Image size 2352x1568, retinal fundus photograph:
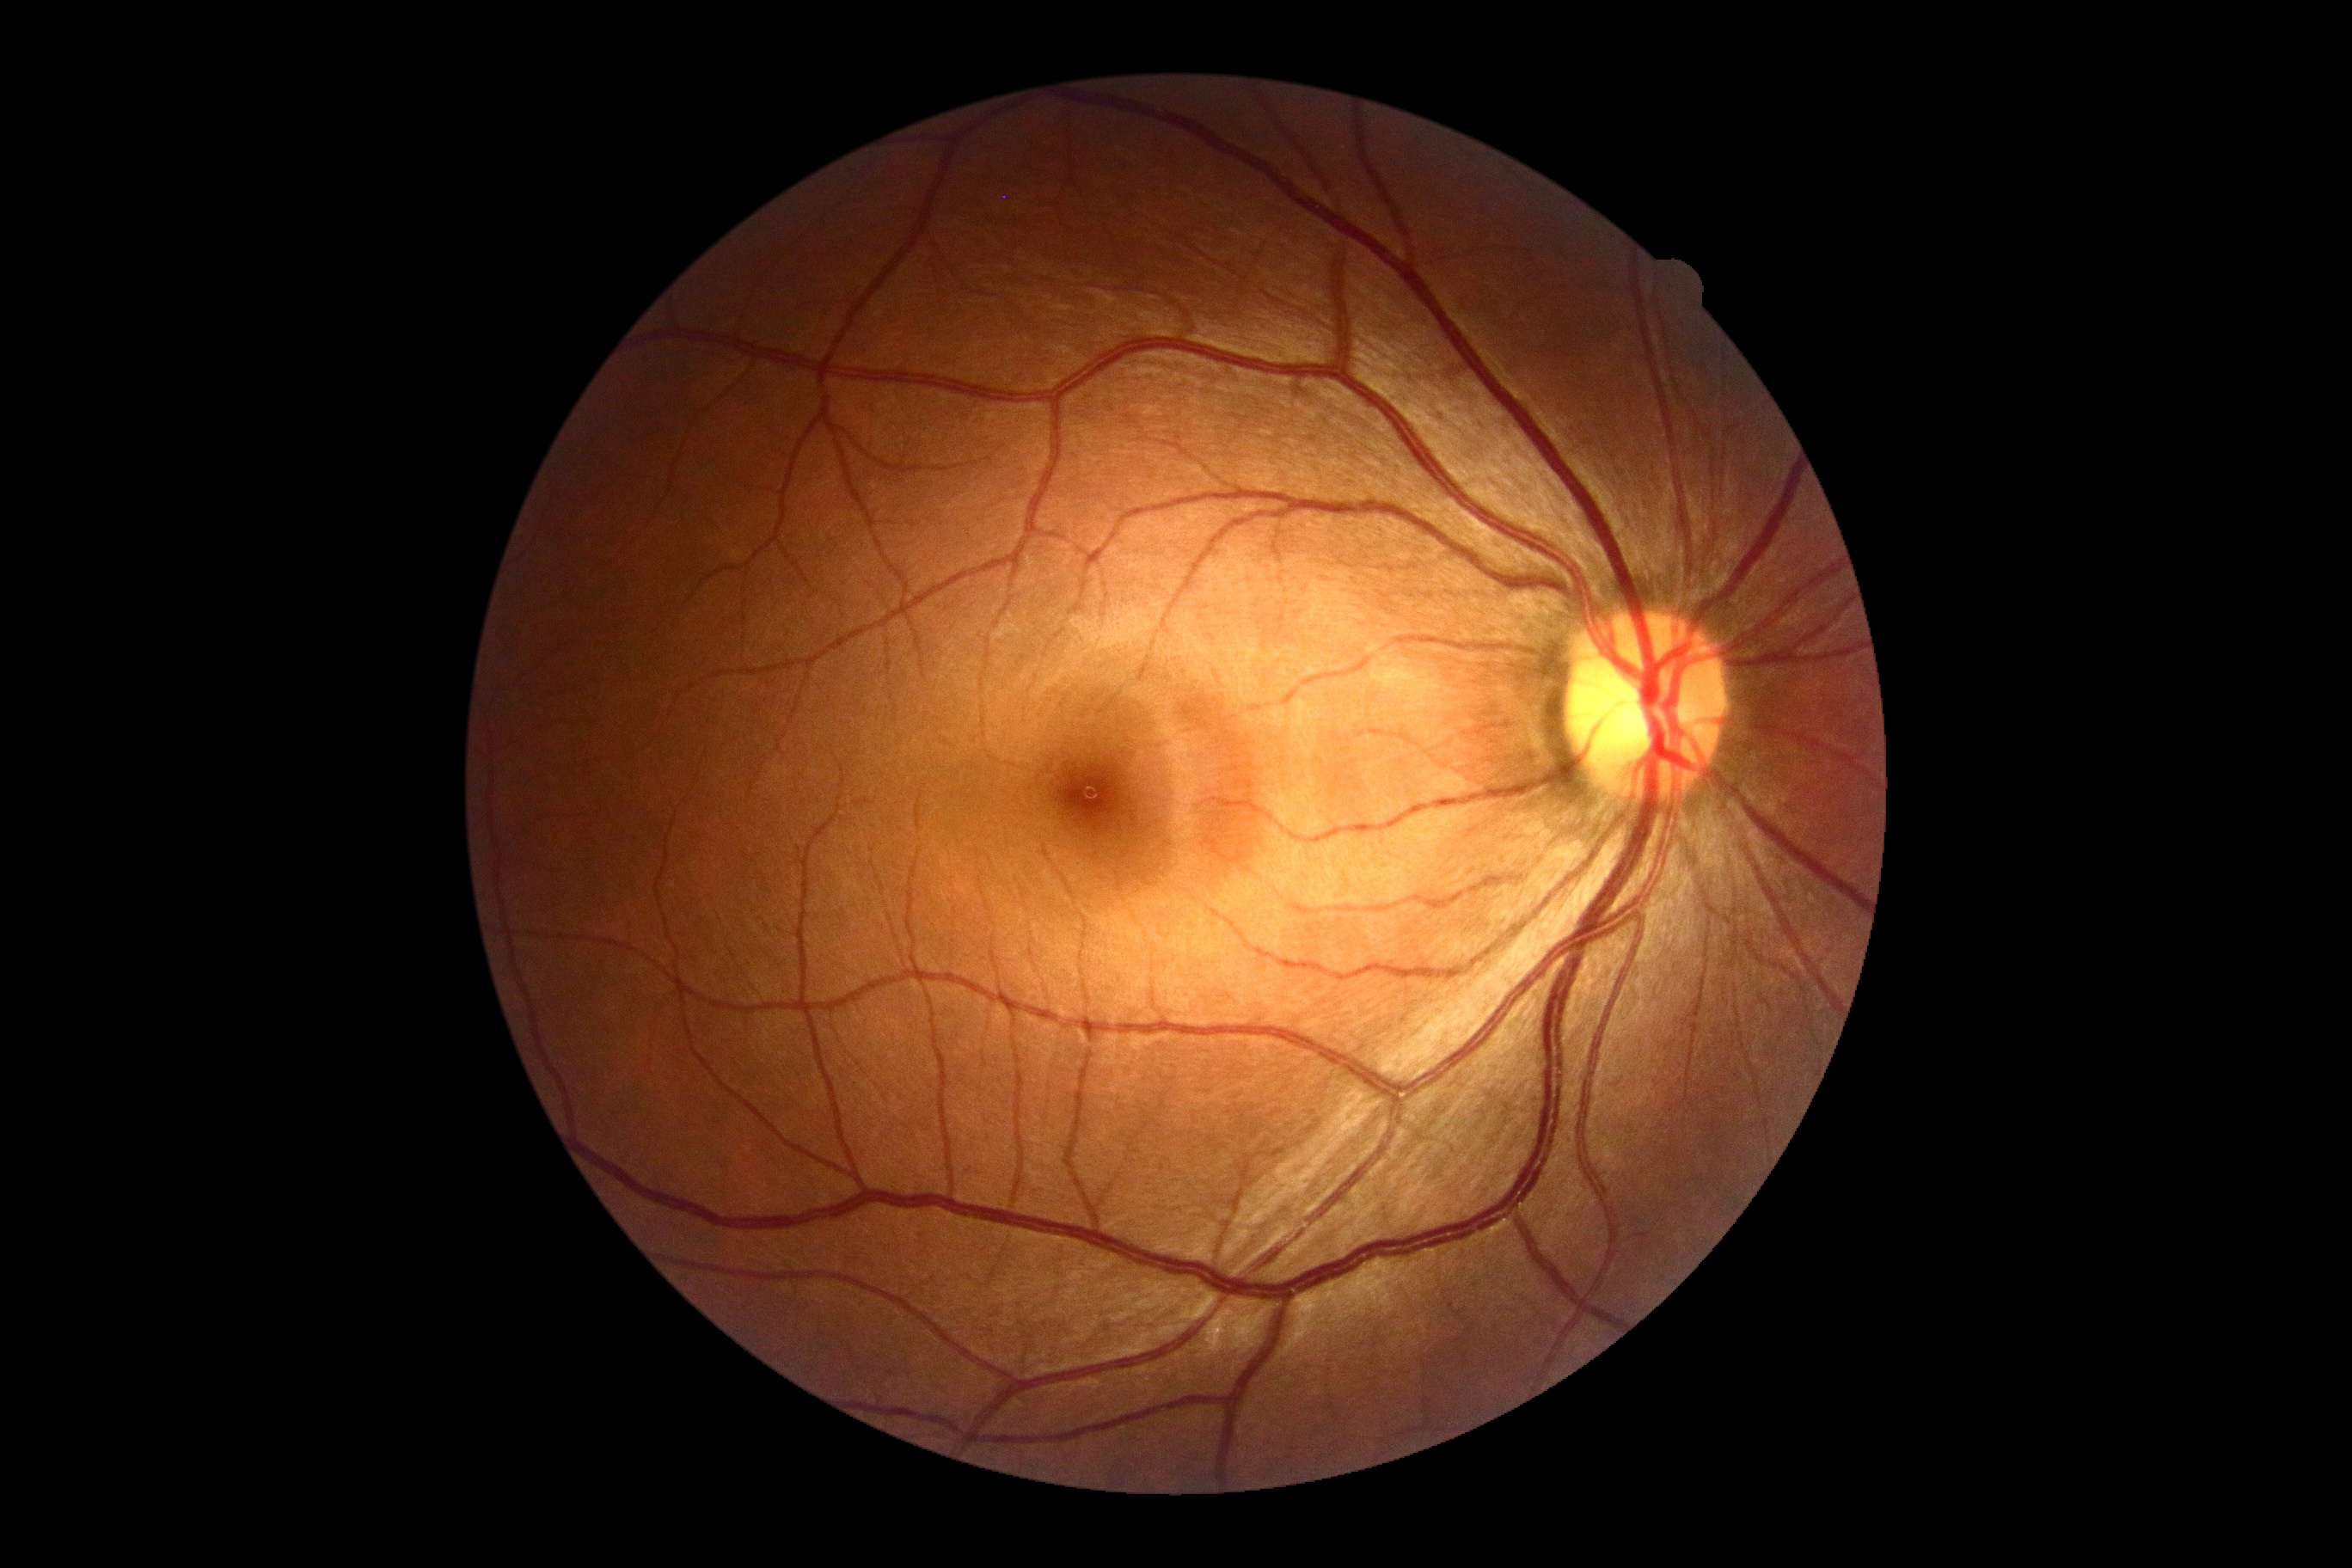 DR stage: 0/4. No DR findings.